45-degree field of view
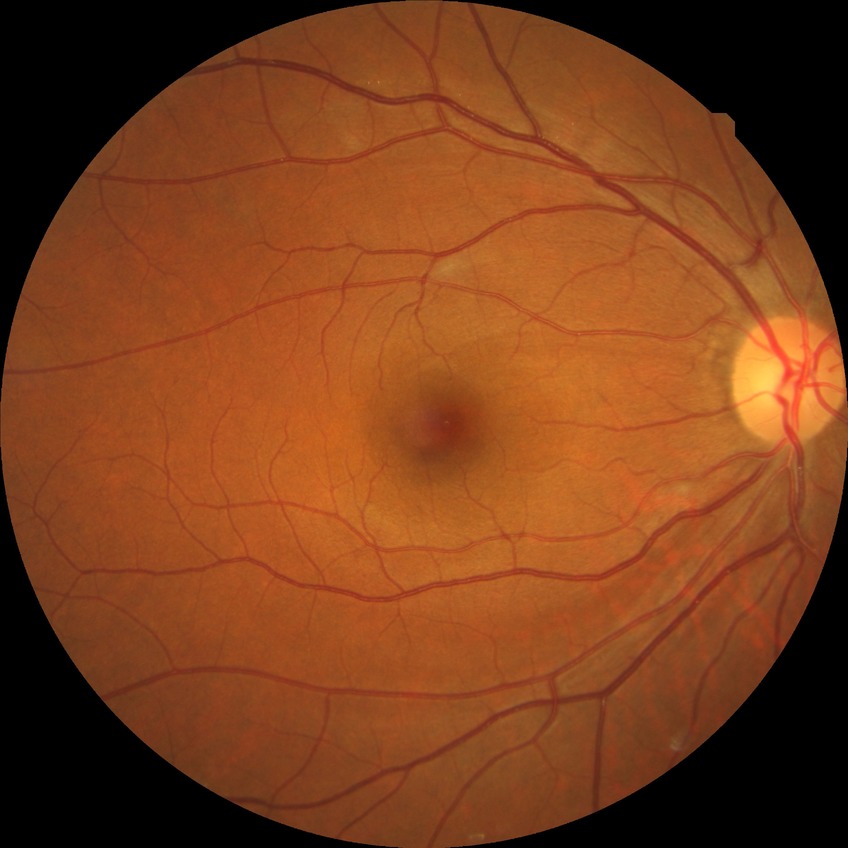
Diabetic retinopathy stage is no diabetic retinopathy.